512x512.
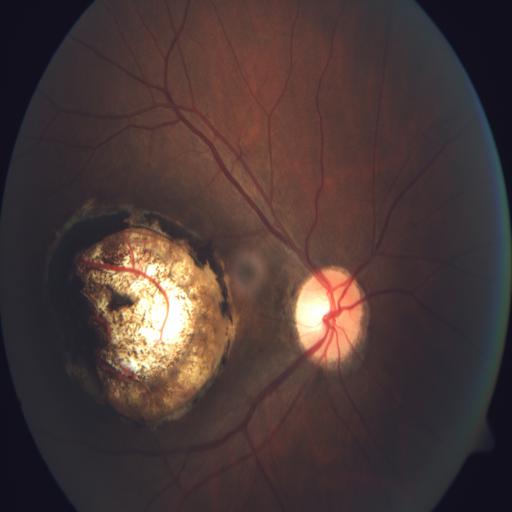
Diagnoses: CB (coloboma).